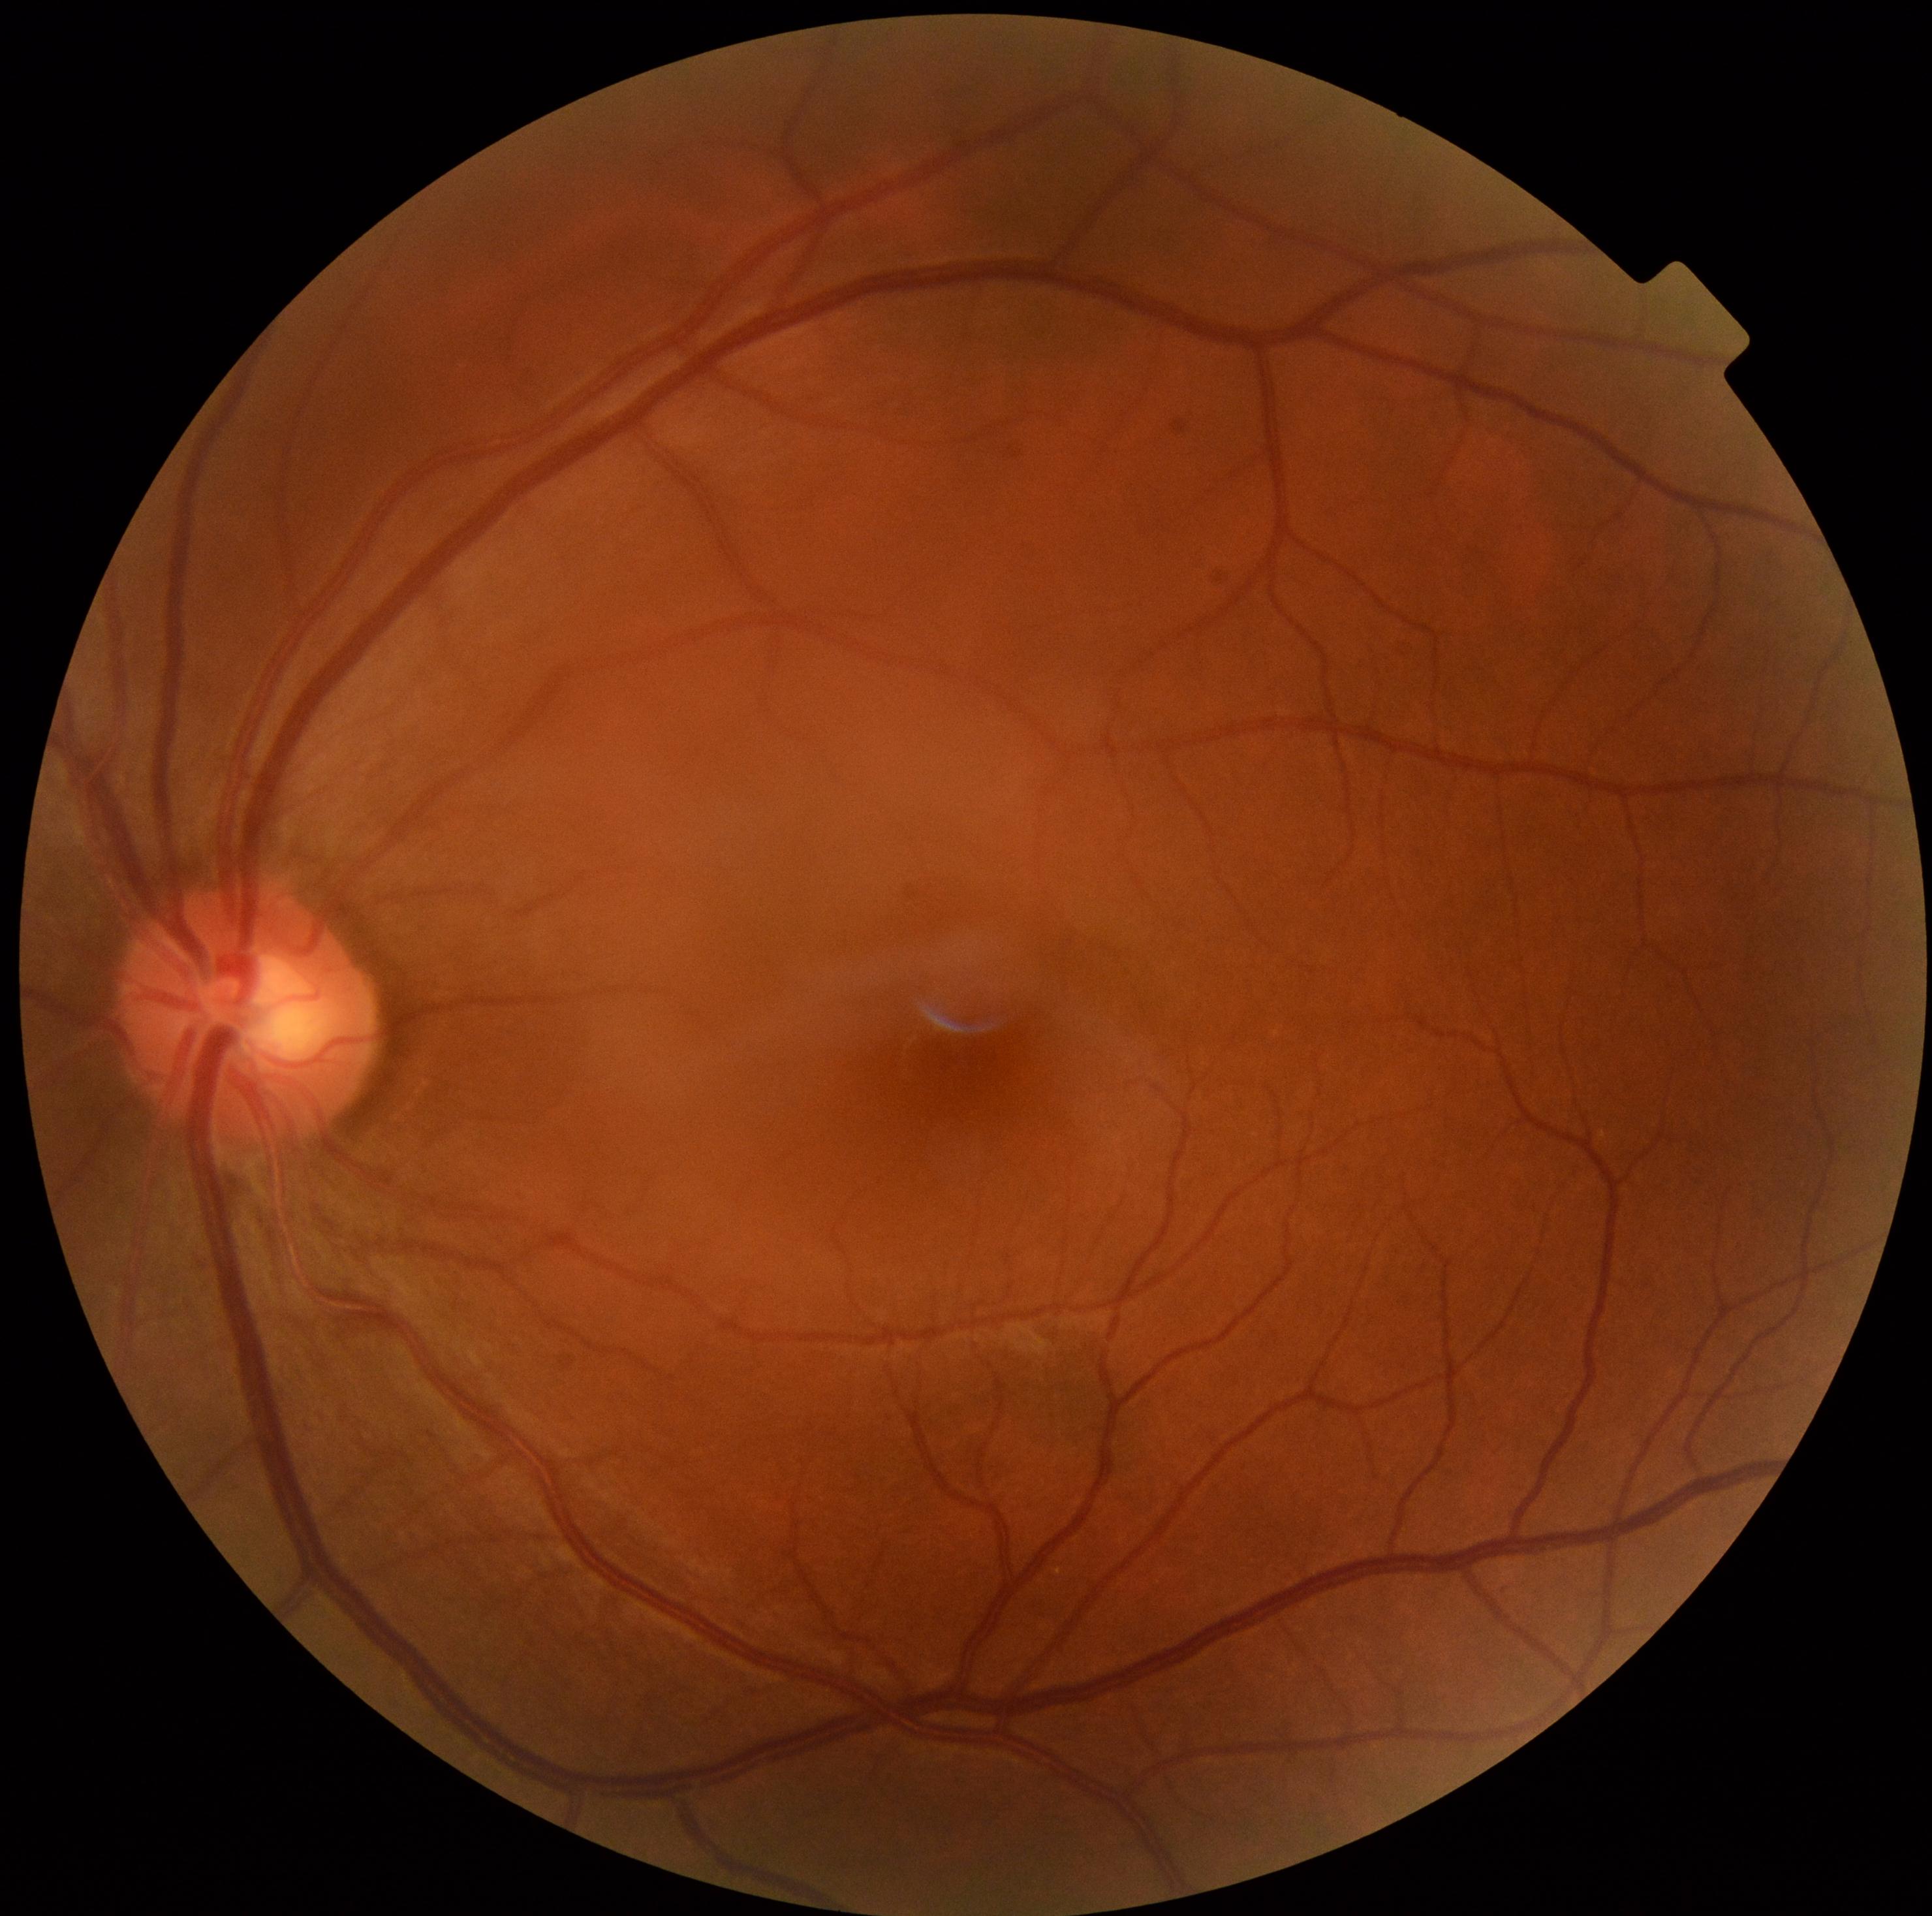 dr_impression: no apparent DR
dr_grade: 0/4 — no visible signs of diabetic retinopathy